Infant wide-field retinal image. Captured with the Phoenix ICON (100° field of view) — 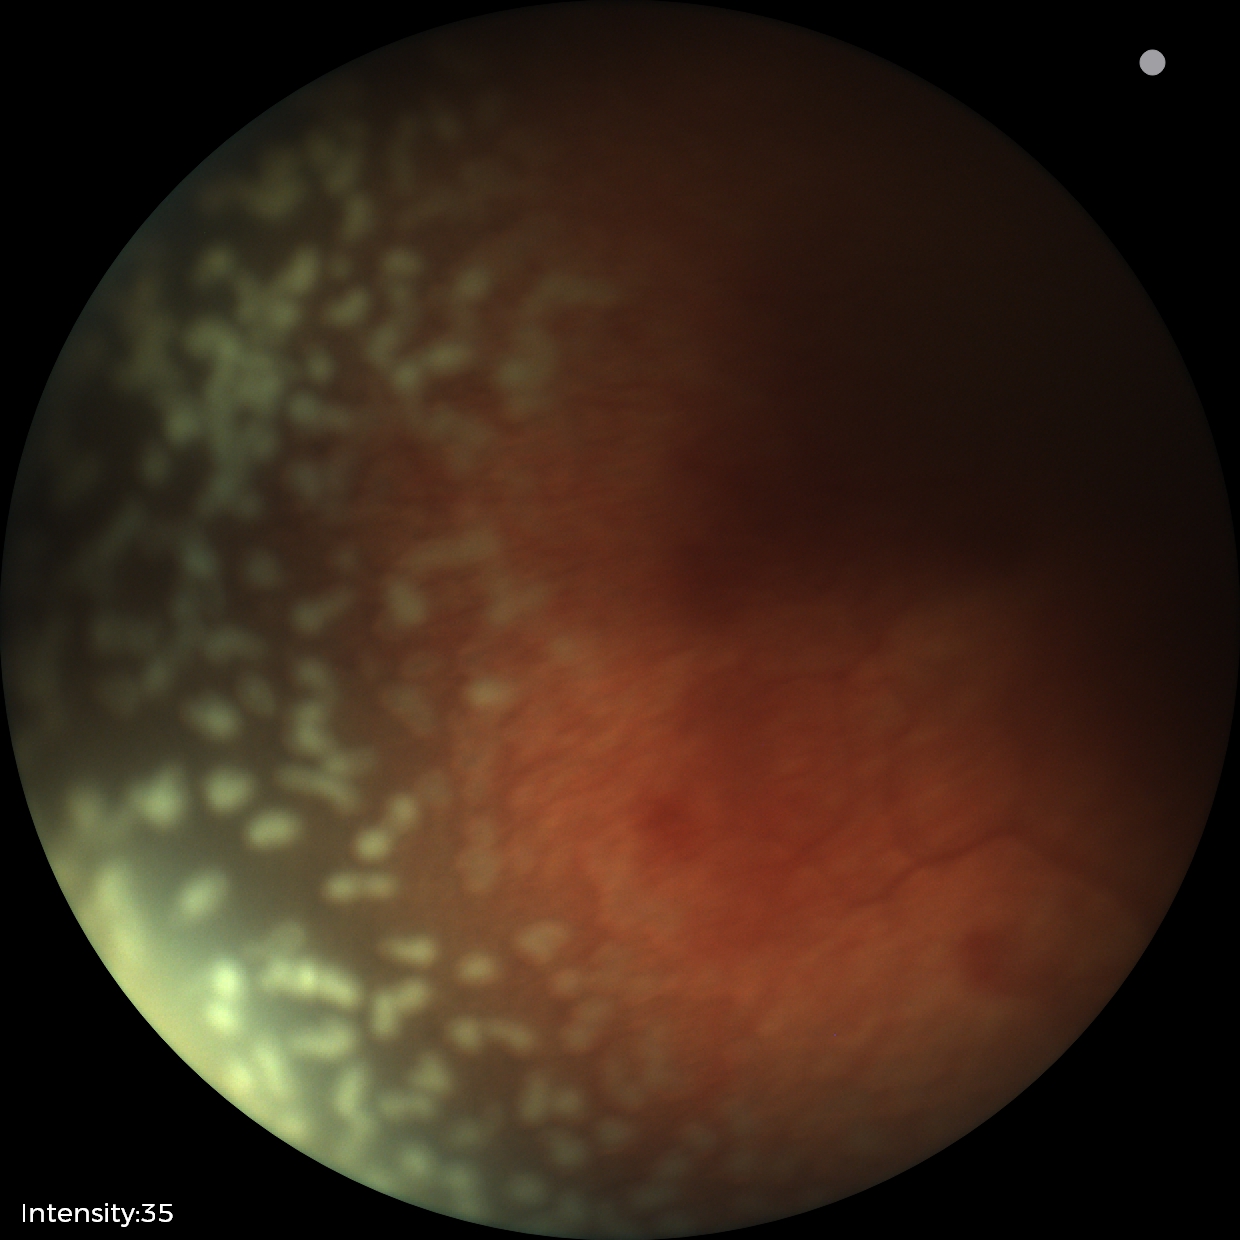
Q: What is the screening diagnosis?
A: retinopathy of prematurity (ROP) stage 2
Q: What is the plus-form classification?
A: plus disease